Retinal fundus photograph. 2048x1536px.
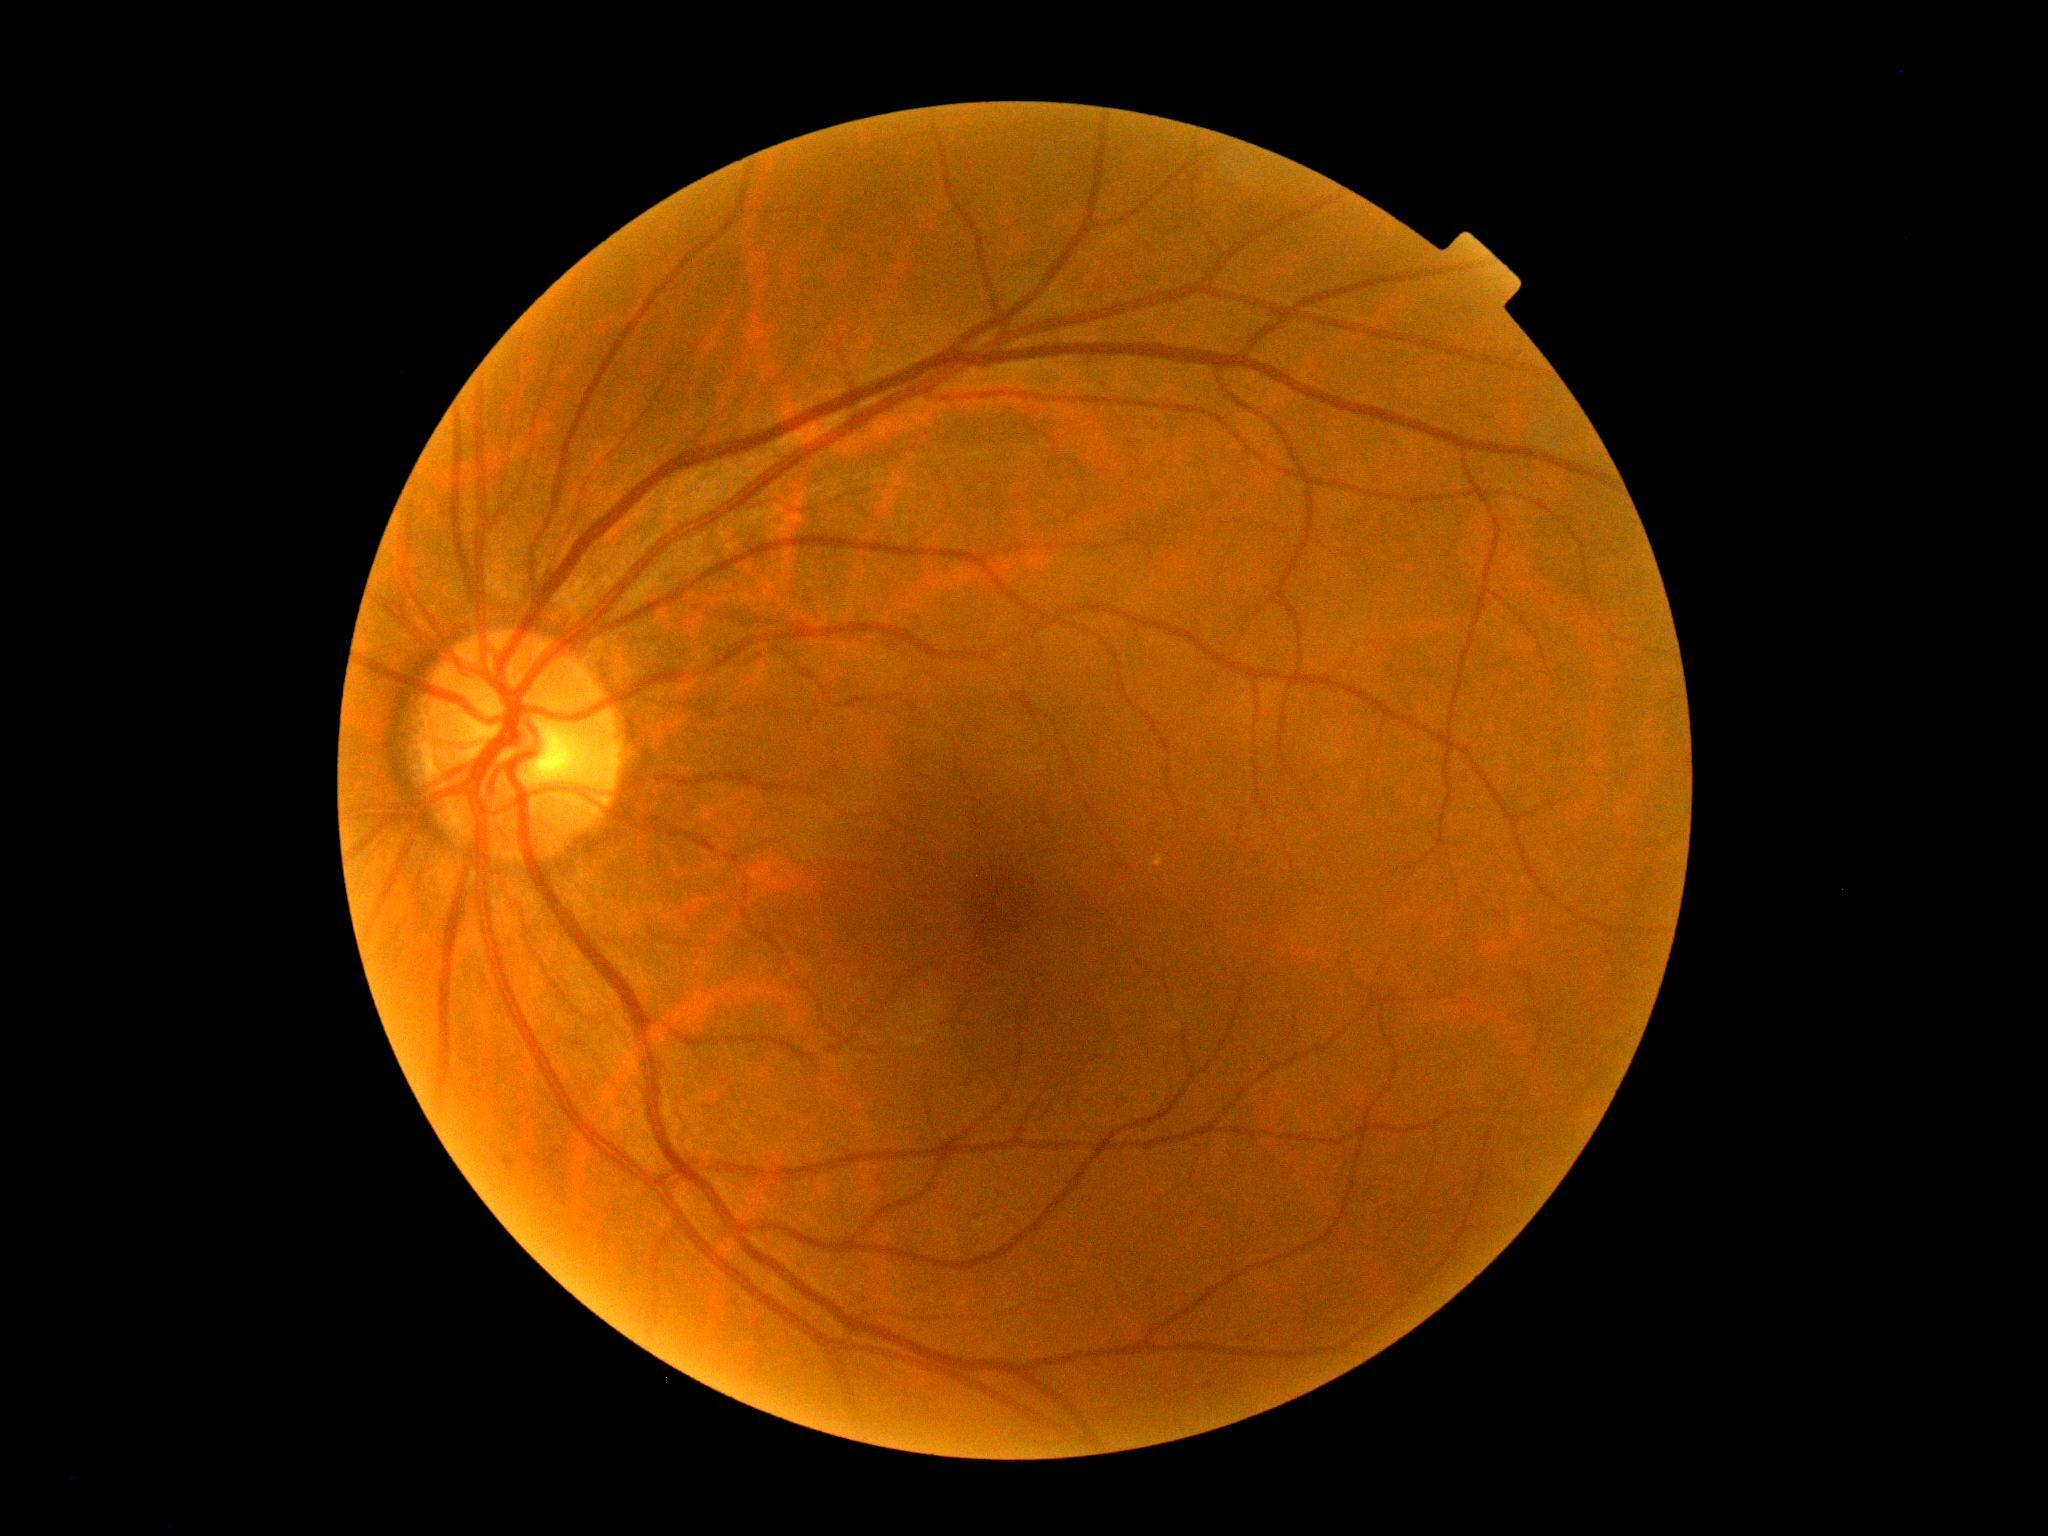
DR: grade 0 (no apparent retinopathy).